45° field of view; 1515 by 1275 pixels; retinal fundus photograph.
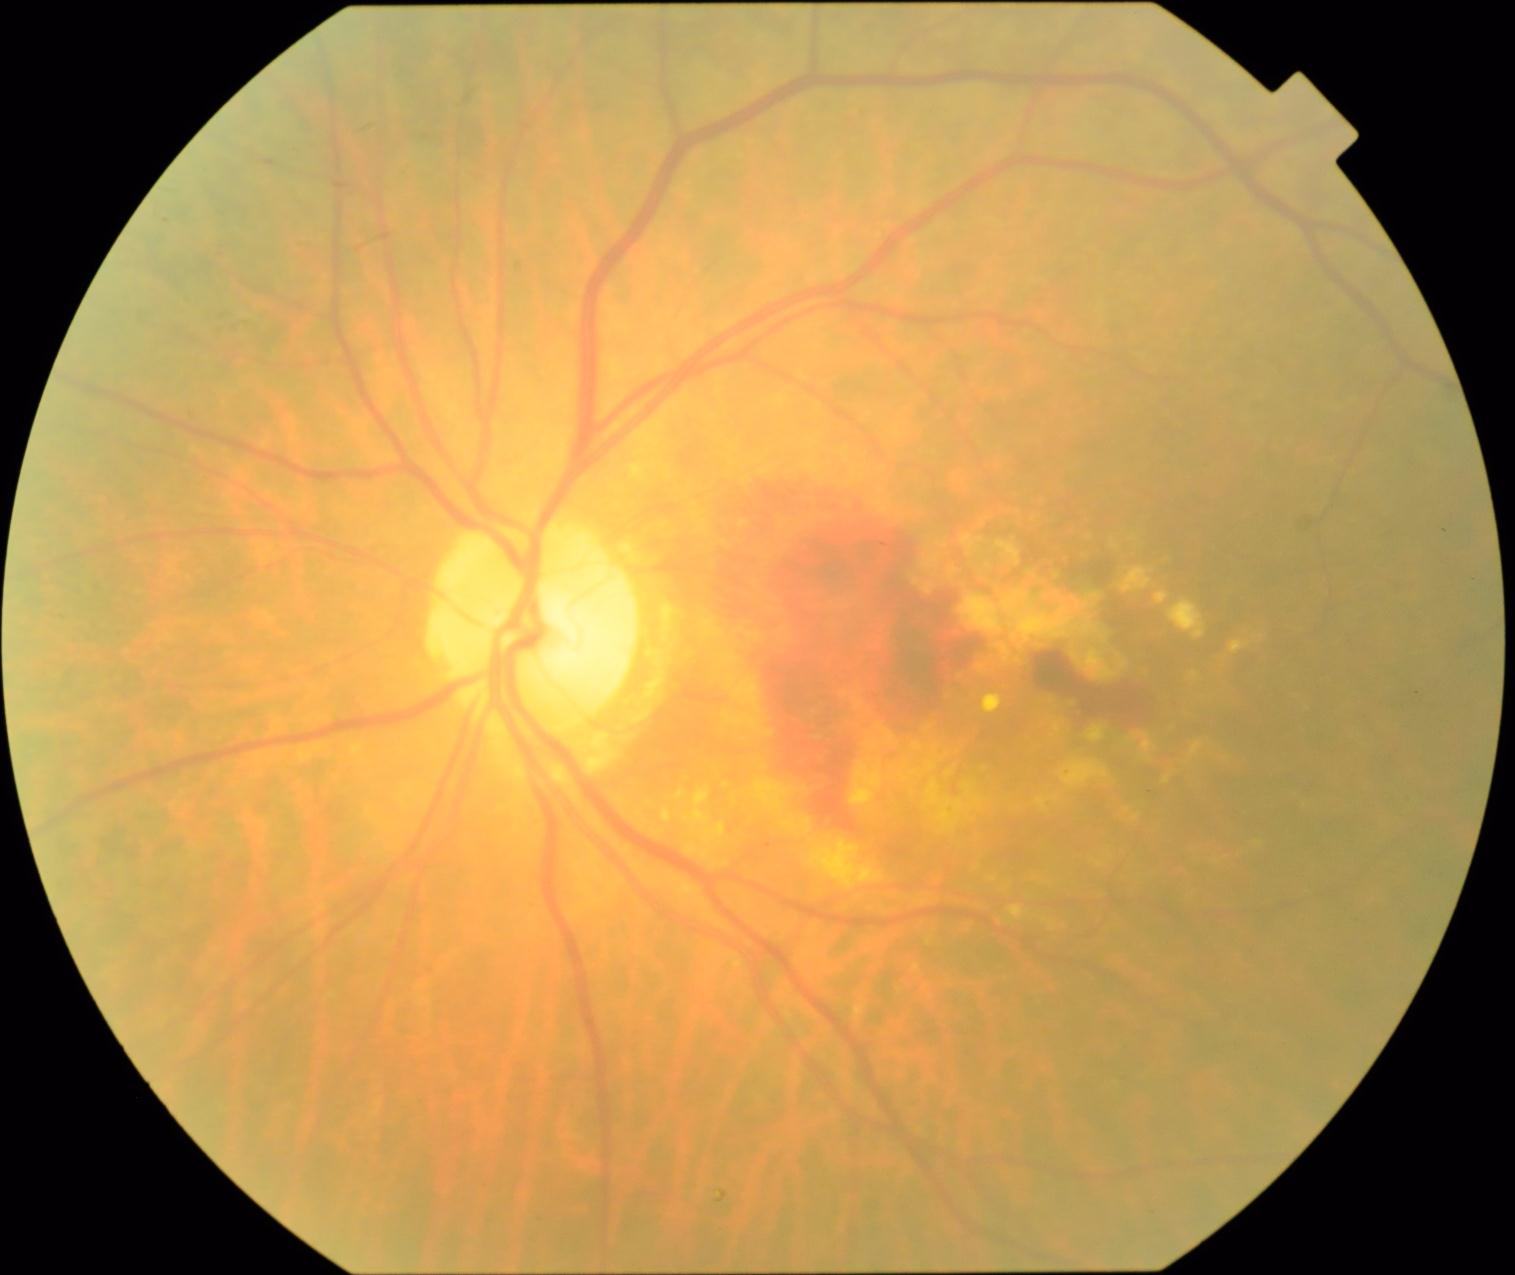 DR grade: 4.